848x848 · nonmydriatic fundus photograph · 45-degree field of view: 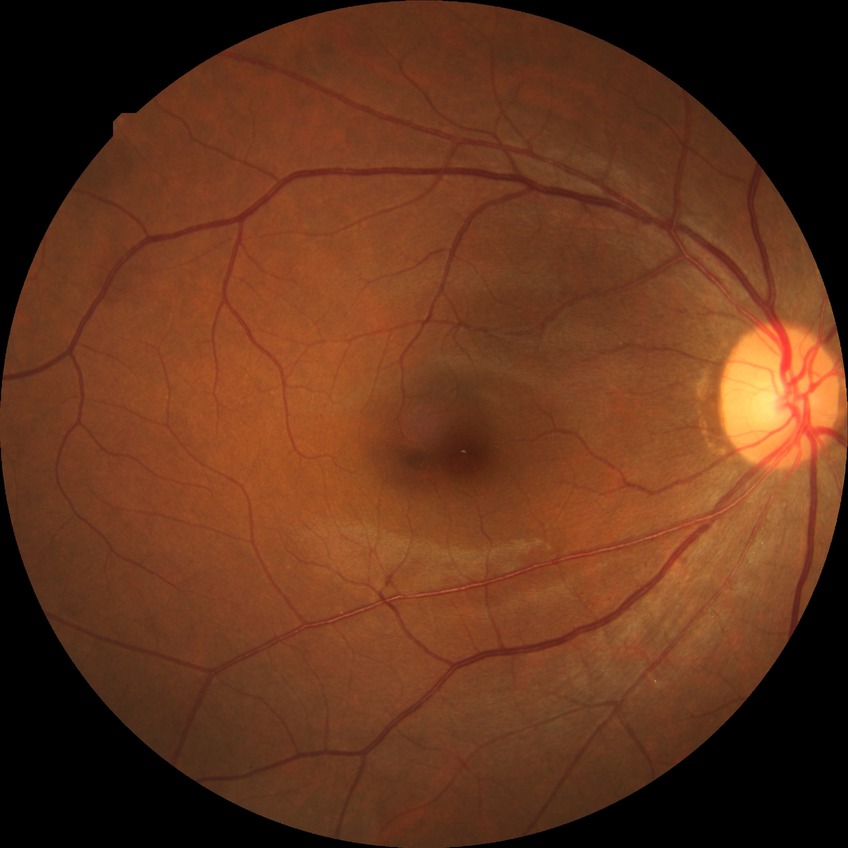
Diabetic retinopathy (DR) is NDR (no diabetic retinopathy).